Camera: Remidio Fundus on Phone (FOP) camera; 1659x2212; CFP
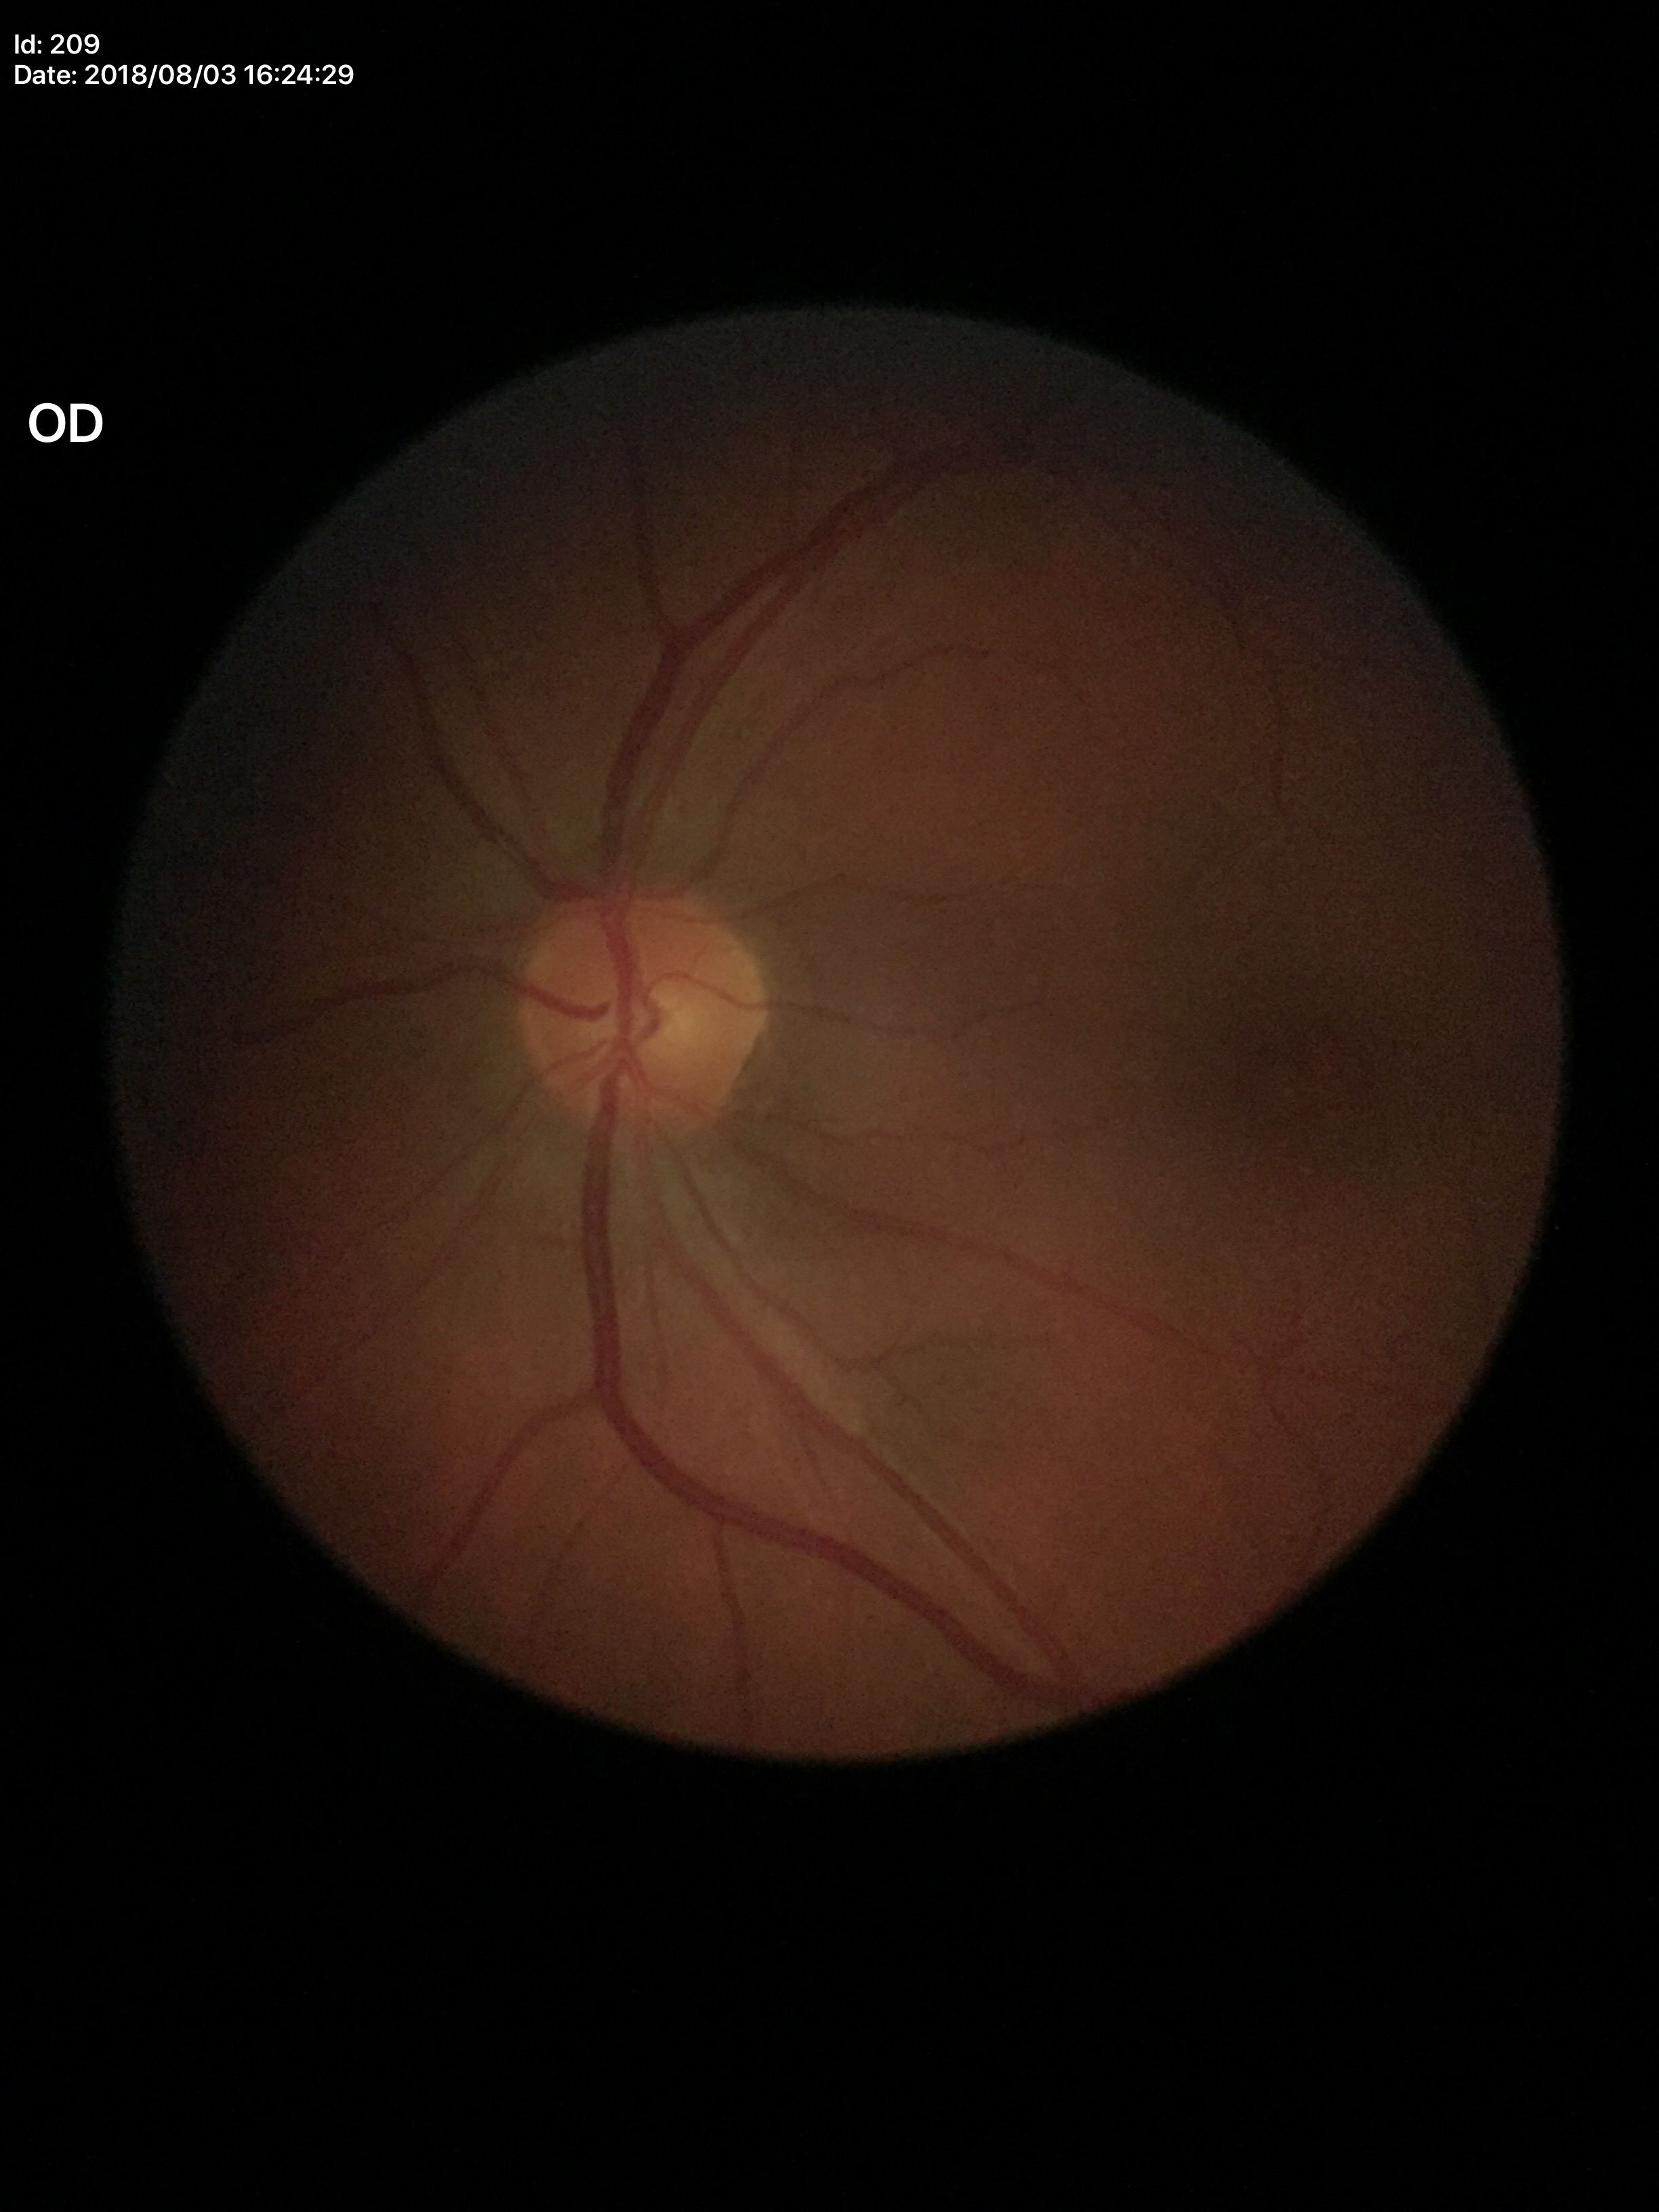 Horizontal C/D ratio (HCDR): 0.40. Not suspicious for glaucoma. Vertical C/D ratio (VCDR): 0.41.